130° field of view (Natus RetCam Envision). Wide-field fundus image from infant ROP screening. Image size 1440x1080: 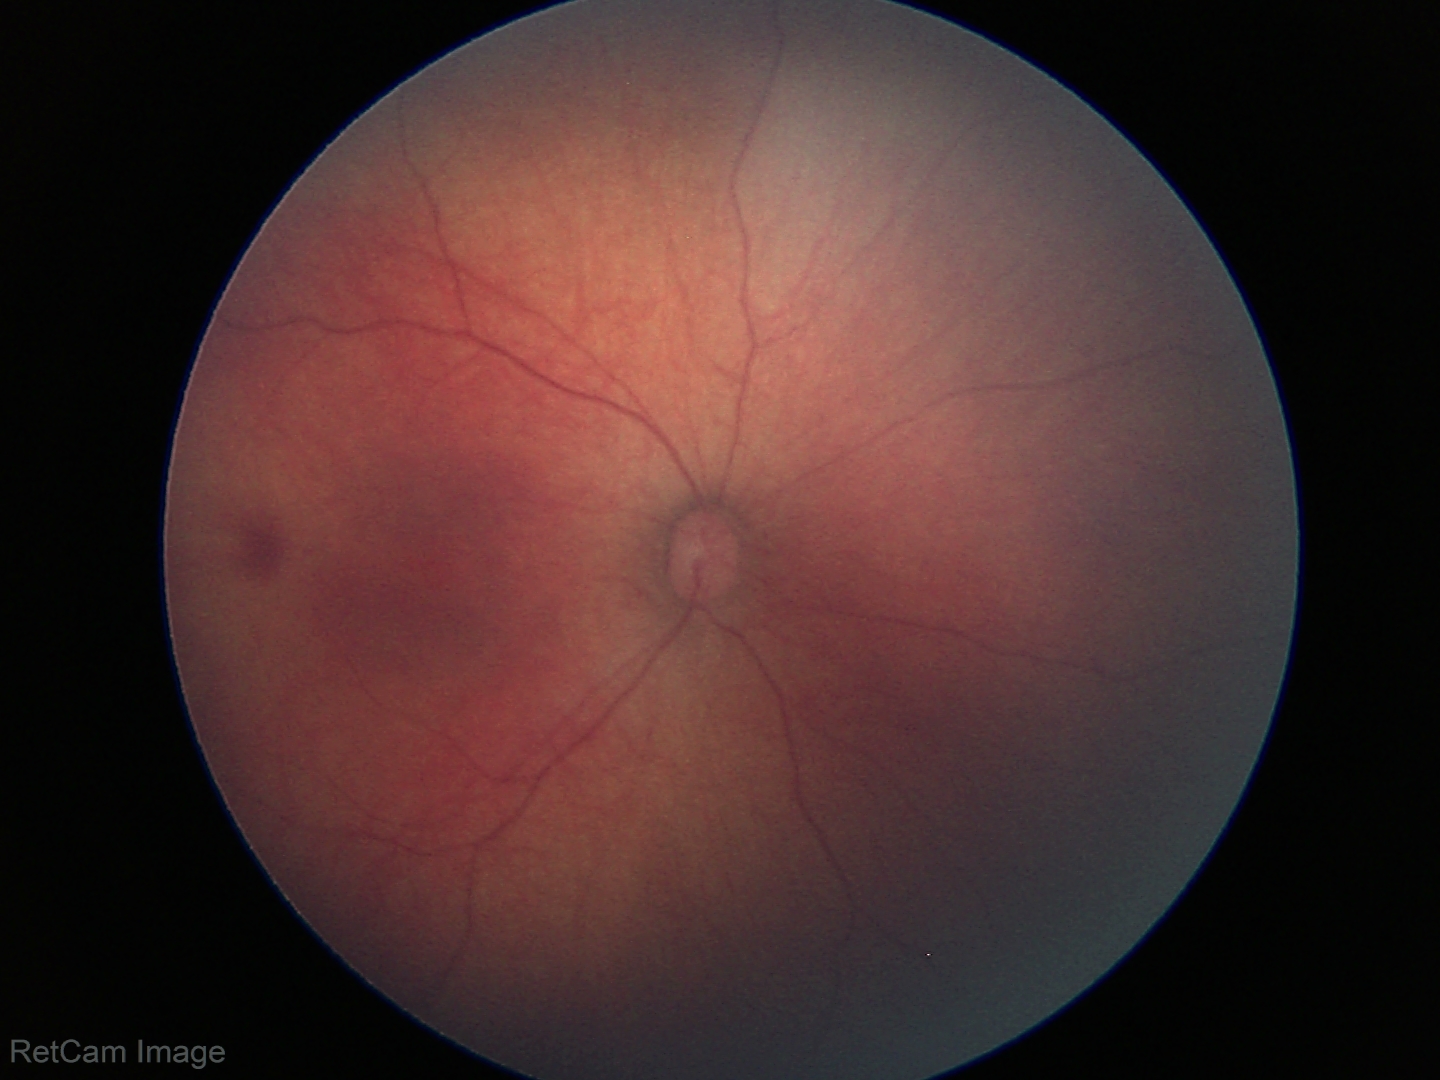
No retinal pathology identified on screening.